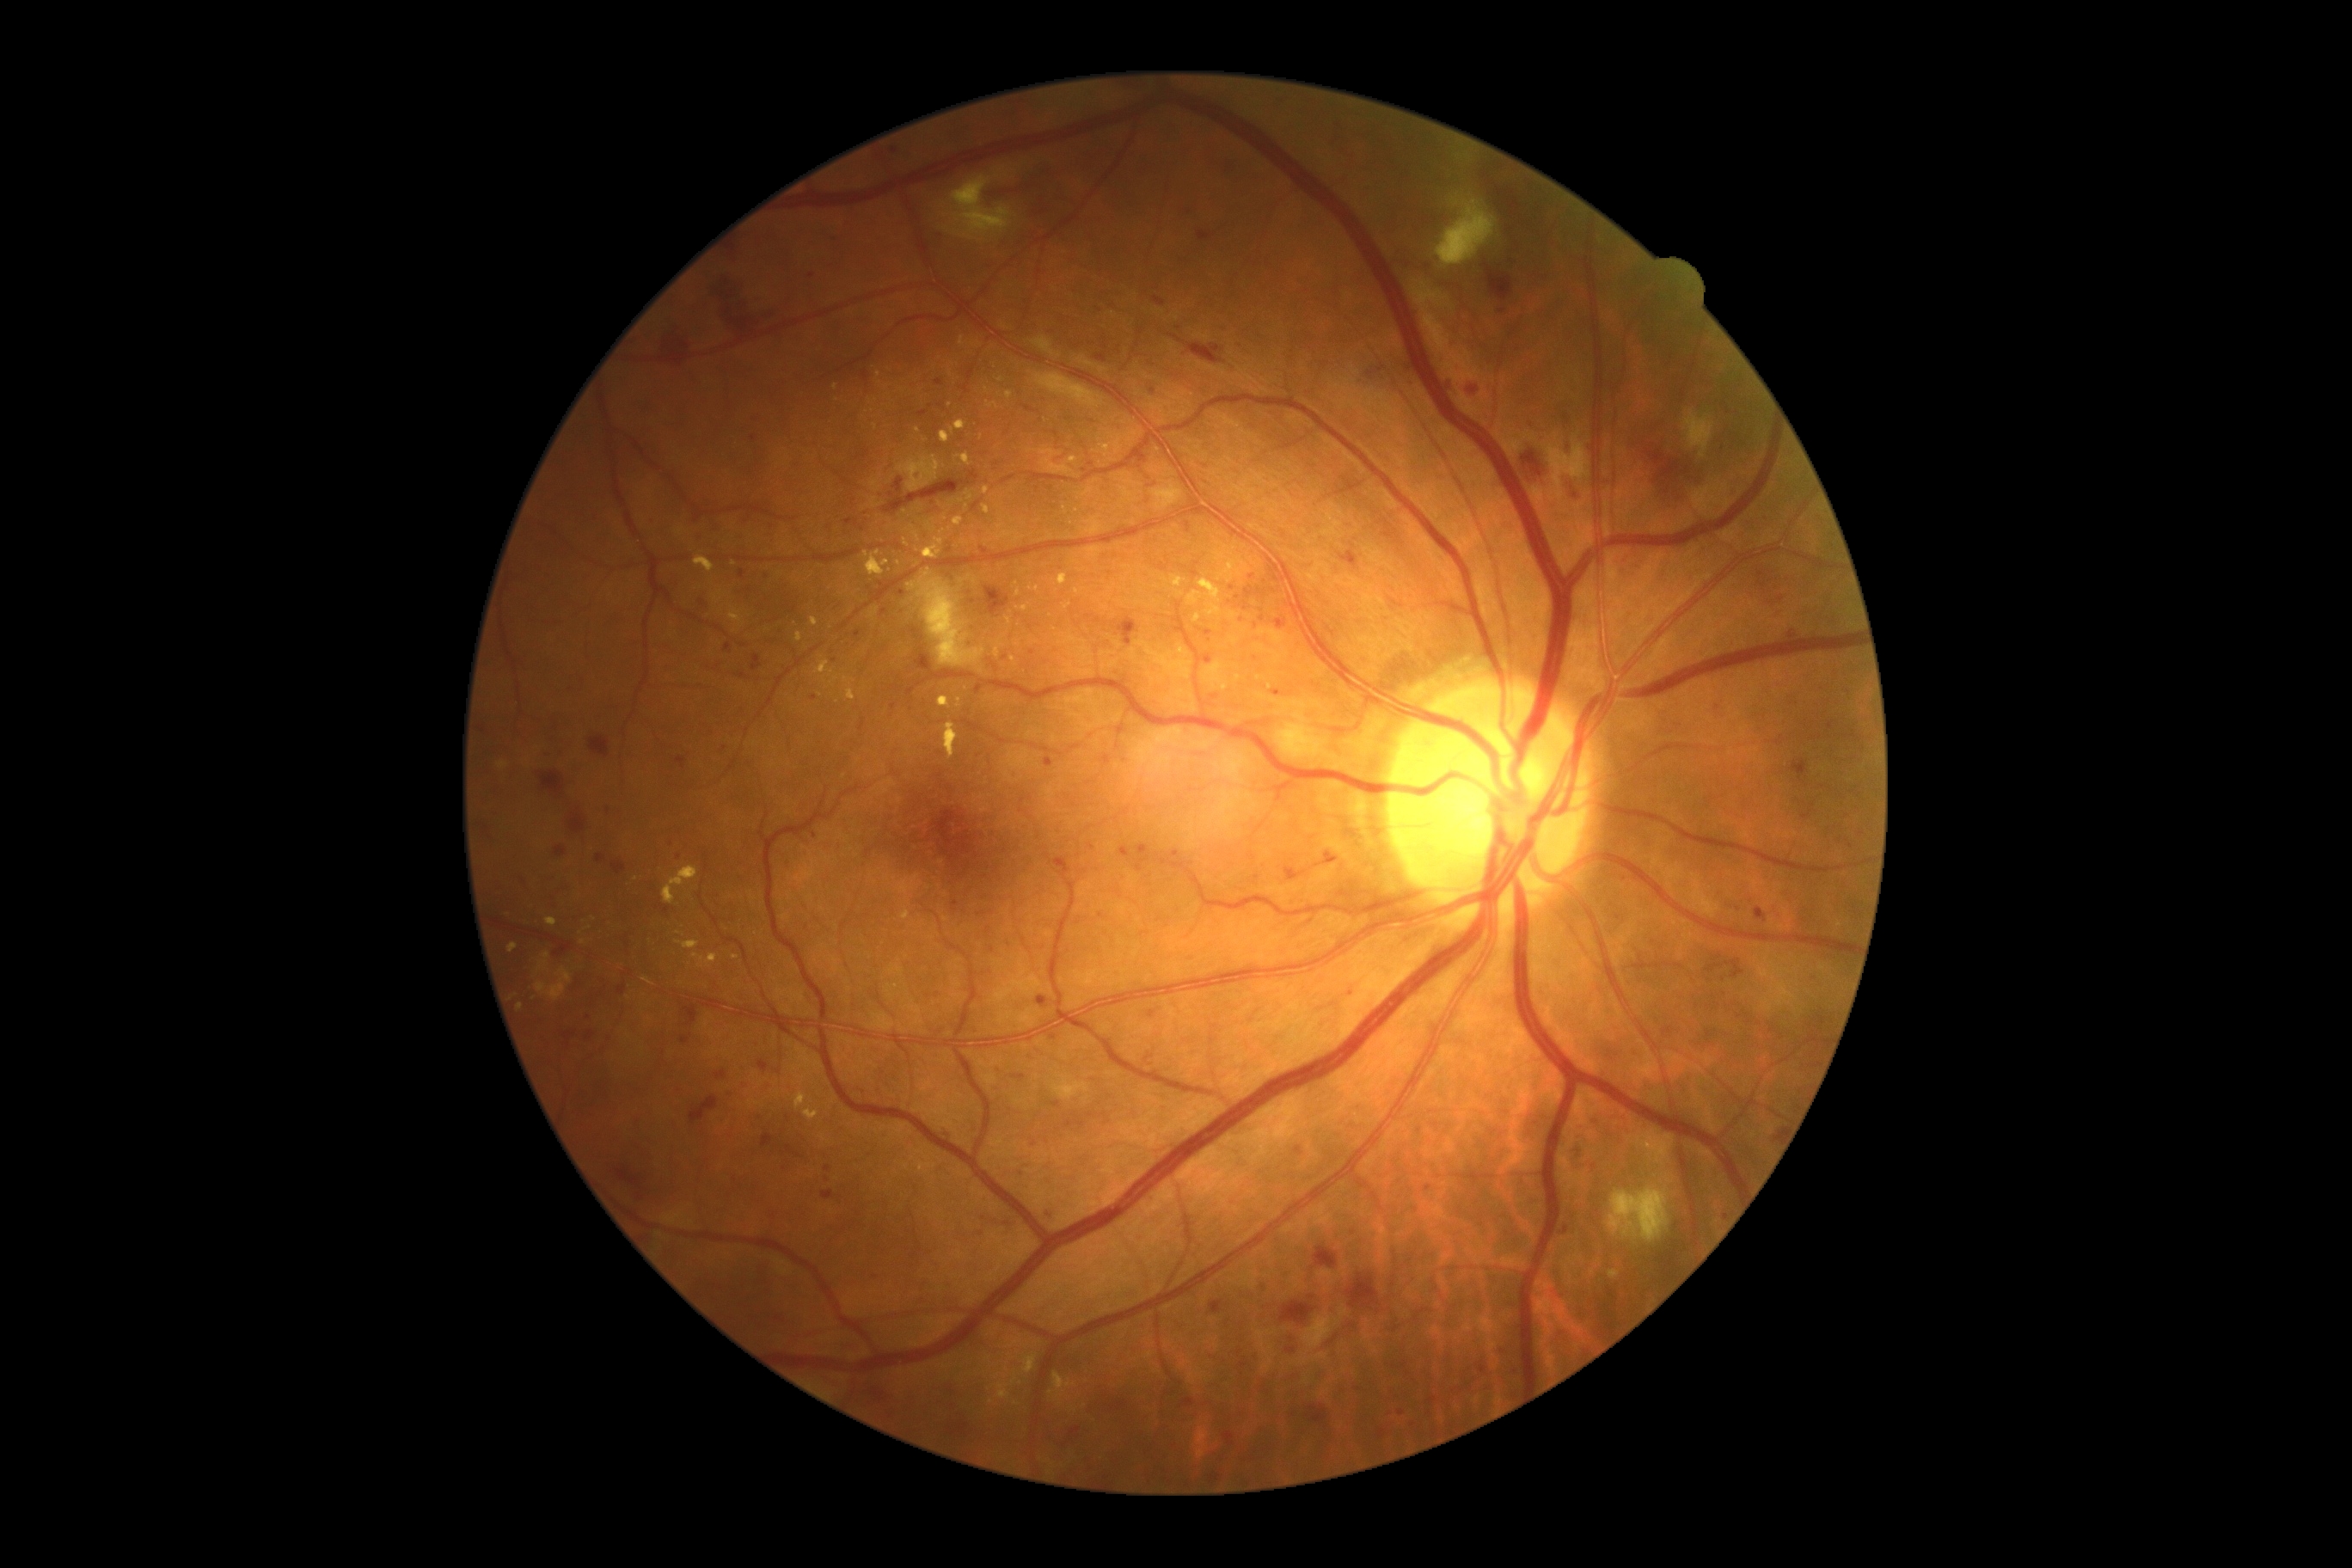 Diabetic retinopathy (DR) is 3/4 — more than 20 intraretinal hemorrhages in each of 4 quadrants, definite venous beading in 2 or more quadrants, or prominent intraretinal microvascular abnormalities in 1 or more quadrants, with no signs of proliferative retinopathy. Microaneurysms (MAs) are present, including at x1=1015 y1=1168 x2=1024 y2=1175; x1=680 y1=1038 x2=690 y2=1044; x1=1791 y1=628 x2=1799 y2=639; x1=752 y1=665 x2=761 y2=671. Additional small MAs near <pt>1005,658</pt>; <pt>891,496</pt>; <pt>749,516</pt>; <pt>732,1093</pt>; <pt>1245,609</pt>; <pt>1128,643</pt>; <pt>1139,848</pt>; <pt>1208,660</pt>; <pt>833,662</pt>; <pt>884,612</pt>; <pt>1152,1015</pt>; <pt>746,1087</pt>. Hemorrhages (HEs) are present, including at x1=1225 y1=164 x2=1240 y2=183; x1=1761 y1=570 x2=1785 y2=604; x1=1199 y1=230 x2=1211 y2=242; x1=873 y1=1392 x2=897 y2=1406; x1=759 y1=1060 x2=768 y2=1072; x1=986 y1=587 x2=1010 y2=616; x1=1589 y1=1117 x2=1600 y2=1125; x1=1292 y1=1337 x2=1301 y2=1344; x1=787 y1=1146 x2=802 y2=1158; x1=1185 y1=205 x2=1199 y2=217; x1=1801 y1=811 x2=1813 y2=821; x1=556 y1=847 x2=567 y2=859; x1=1314 y1=1247 x2=1338 y2=1268; x1=1313 y1=1320 x2=1359 y2=1354; x1=1295 y1=1148 x2=1304 y2=1156; x1=570 y1=814 x2=587 y2=835. Additional small HEs near <pt>1503,312</pt>. Hard exudates (EXs) are present, including at x1=797 y1=632 x2=804 y2=642; x1=546 y1=917 x2=558 y2=928; x1=795 y1=1093 x2=807 y2=1110; x1=988 y1=403 x2=998 y2=408; x1=983 y1=486 x2=989 y2=494; x1=812 y1=618 x2=819 y2=627; x1=953 y1=517 x2=964 y2=527; x1=804 y1=1106 x2=819 y2=1122; x1=940 y1=432 x2=952 y2=444; x1=695 y1=556 x2=716 y2=573; x1=1197 y1=580 x2=1222 y2=604. Additional small EXs near <pt>1269,687</pt>; <pt>898,563</pt>; <pt>735,957</pt>; <pt>950,405</pt>; <pt>1017,584</pt>; <pt>1023,572</pt>; <pt>1261,678</pt>; <pt>918,430</pt>.